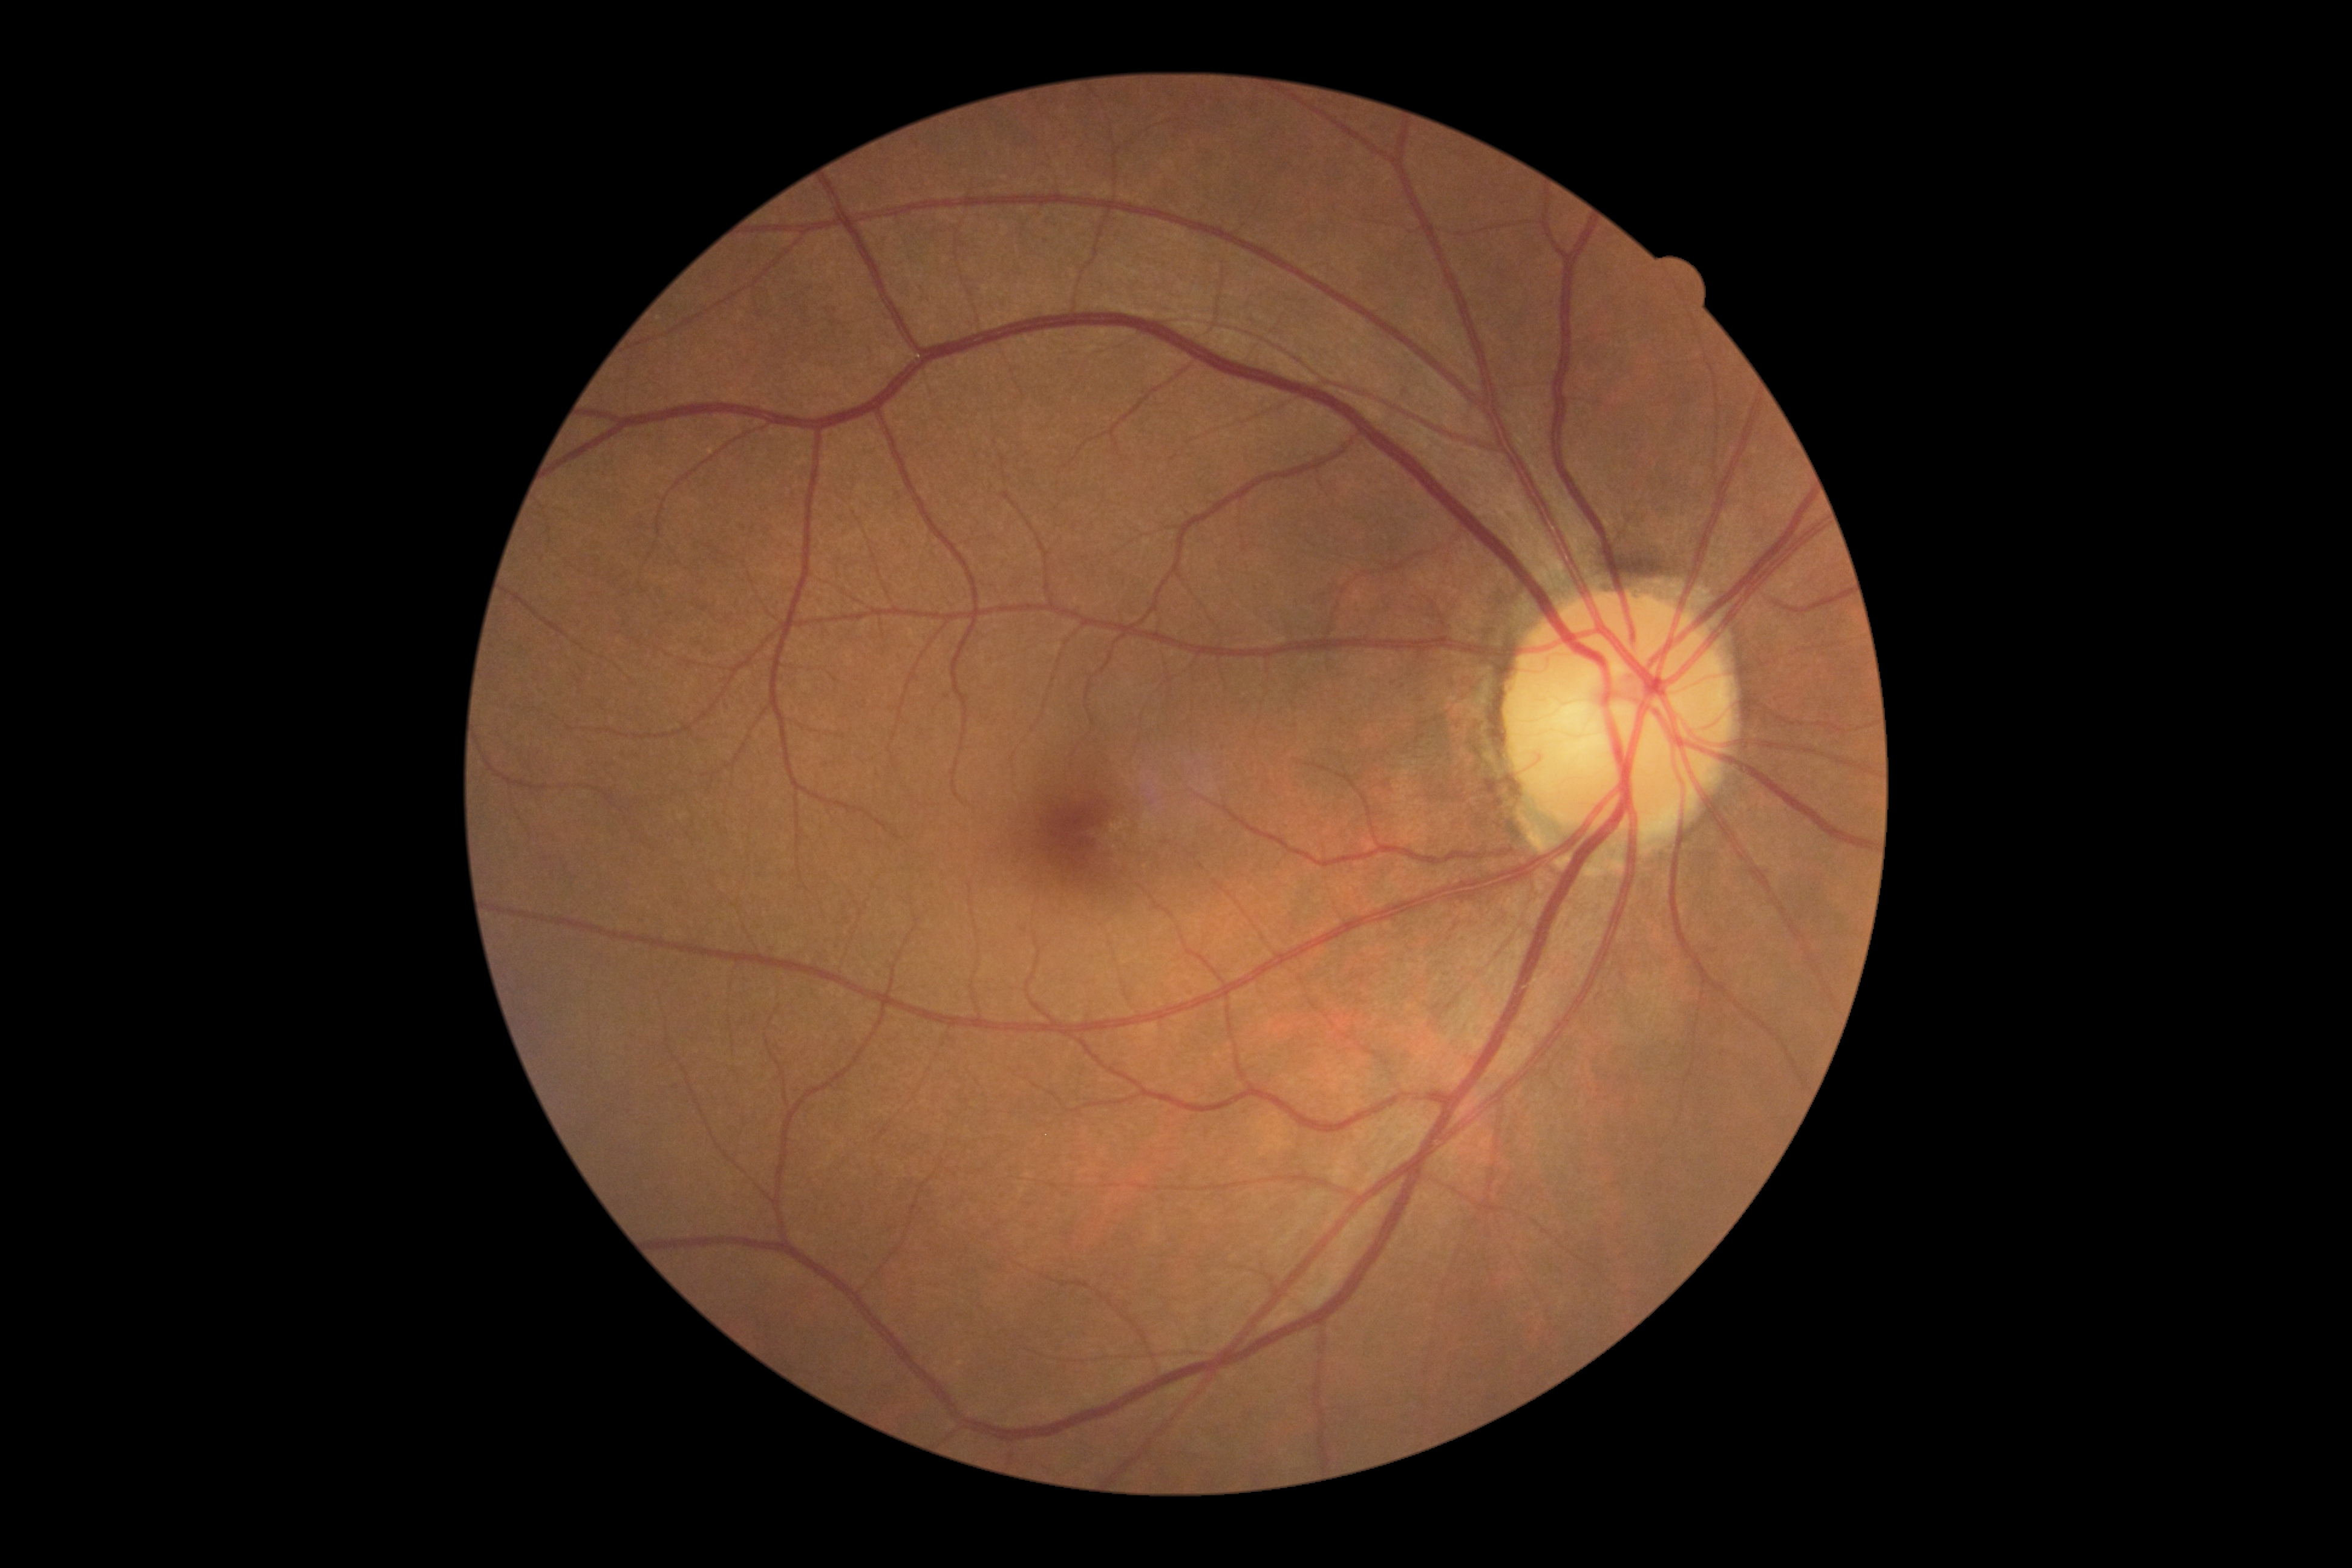 - diabetic retinopathy (DR) — grade 0